45° FOV, color fundus image
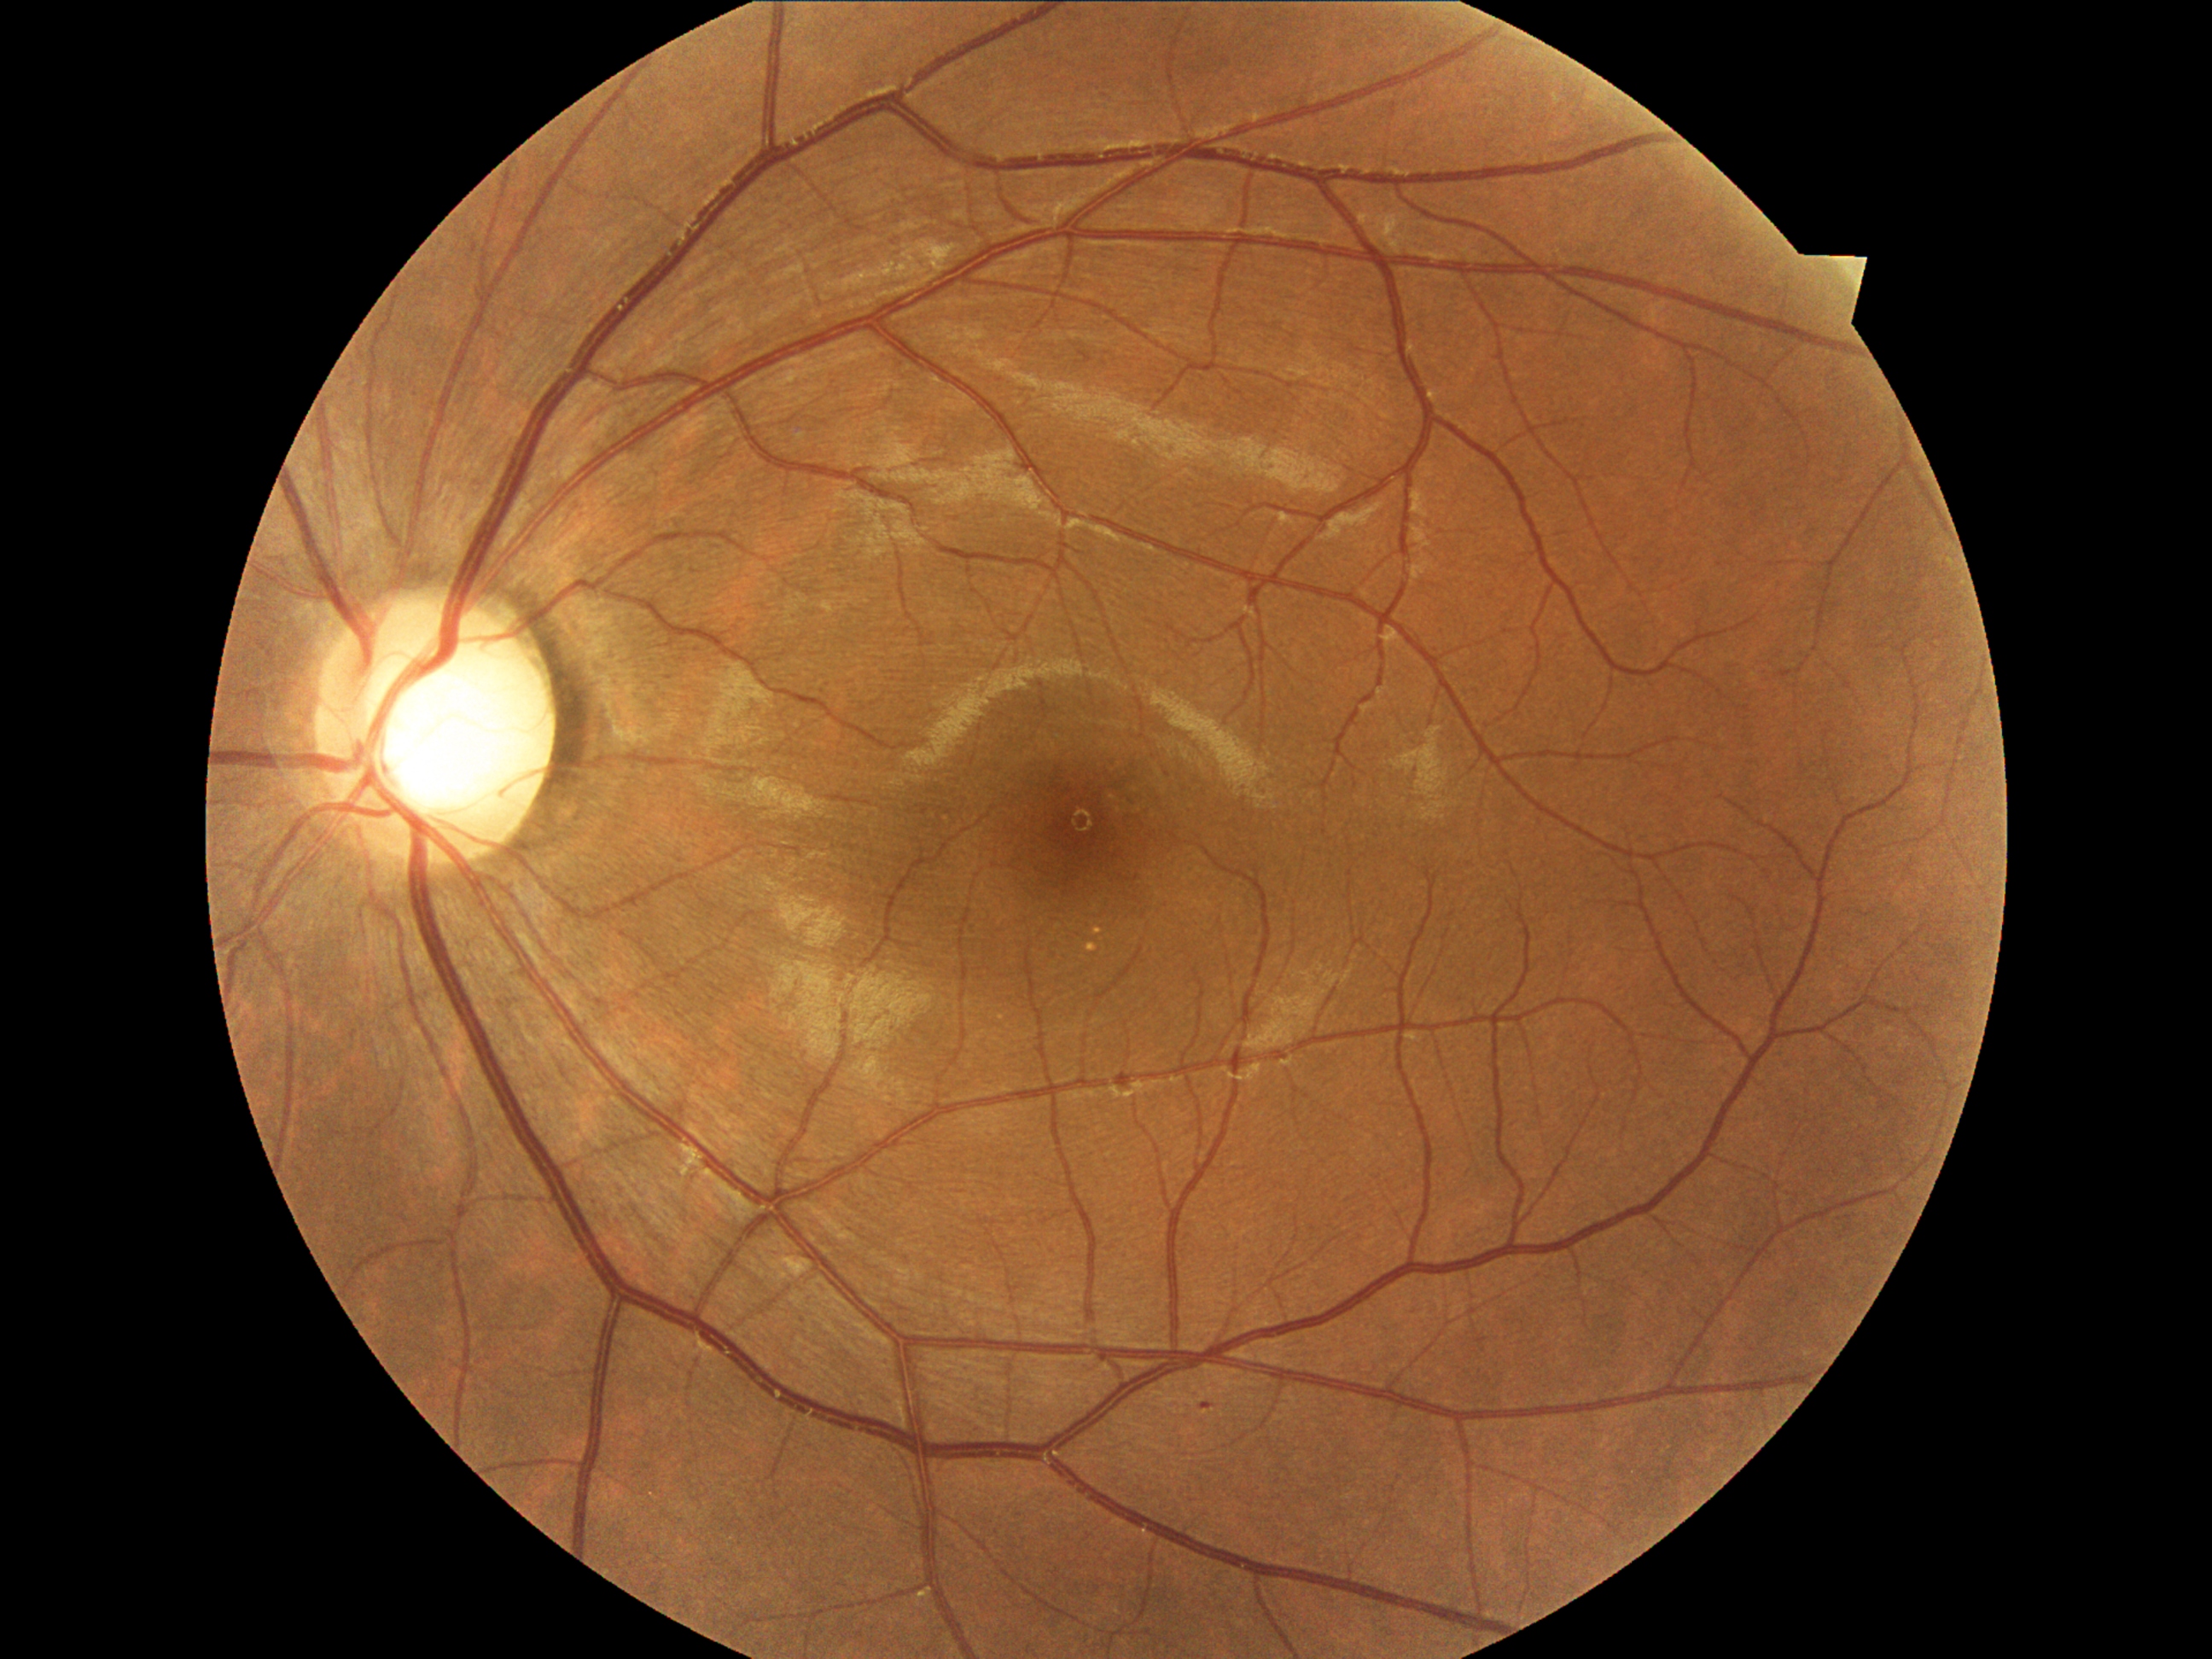 Retinopathy grade: 1
microaneurysms: (1202, 1402, 1213, 1407)
hard exudates: none
soft exudates: none
hemorrhages: none